Optic disc photograph.
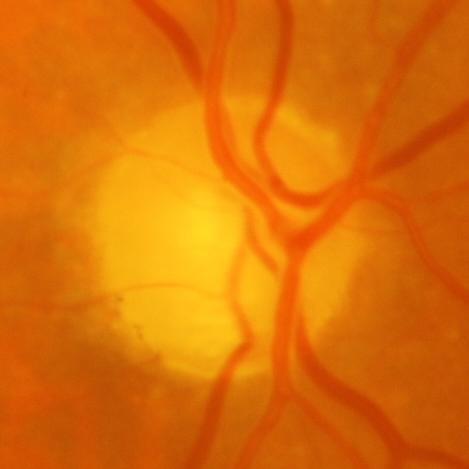 Showing evidence of glaucoma.